Wide-field contact fundus photograph of an infant. 130° field of view (Natus RetCam Envision):
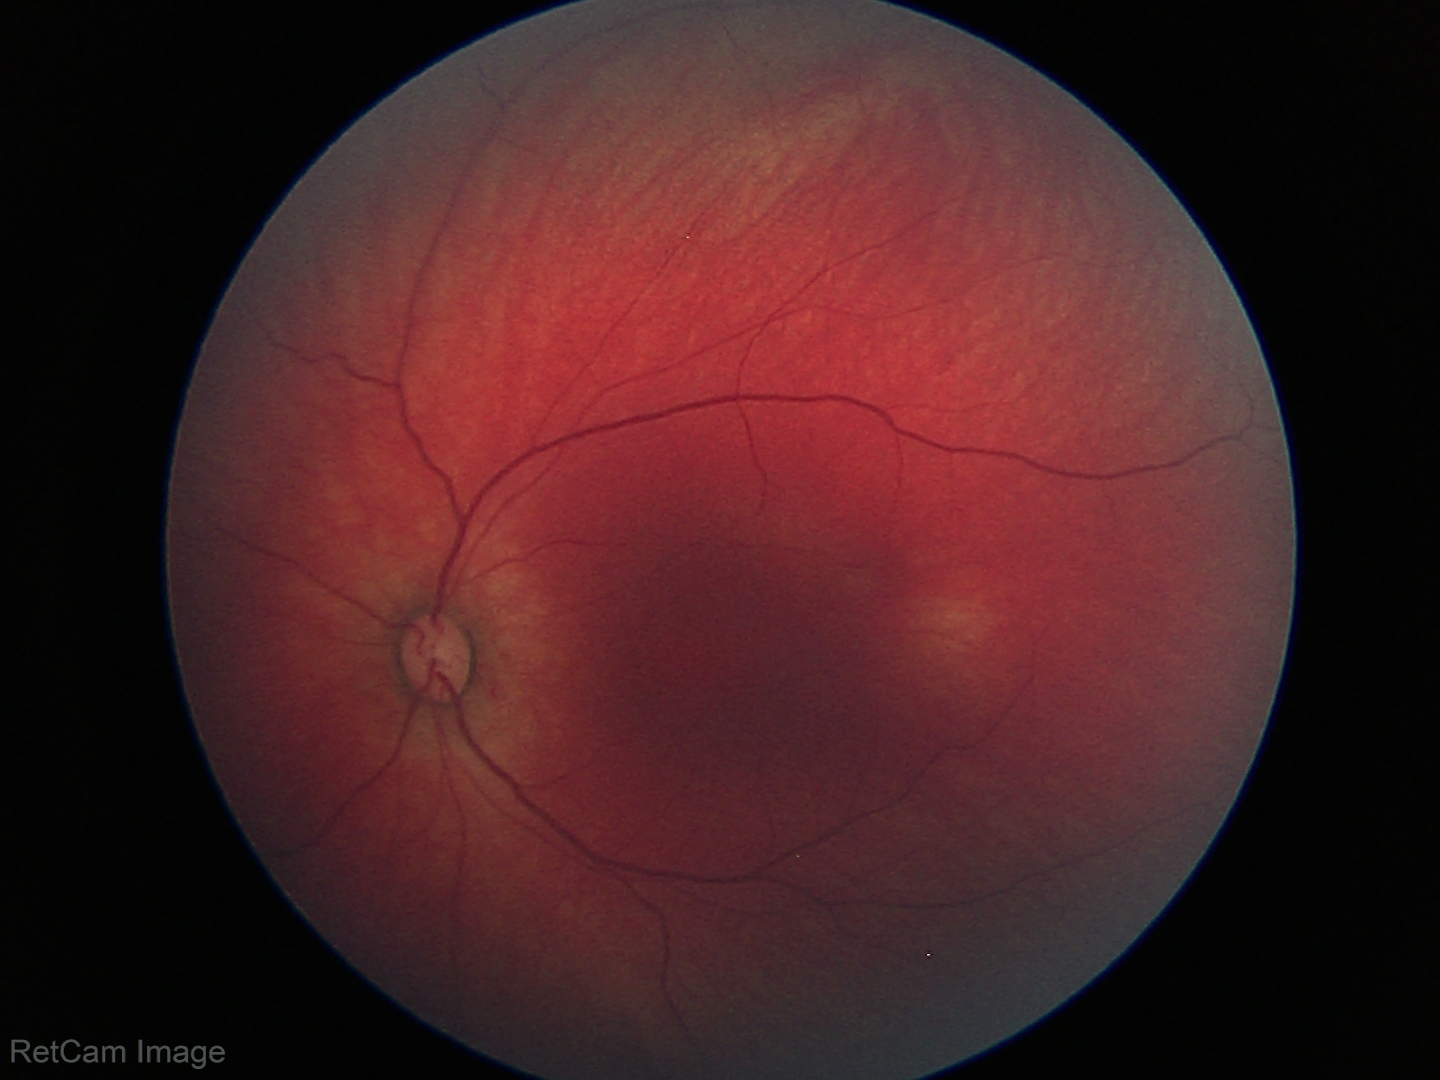
Normal screening examination.